1240x1240. Pediatric retinal photograph (wide-field) — 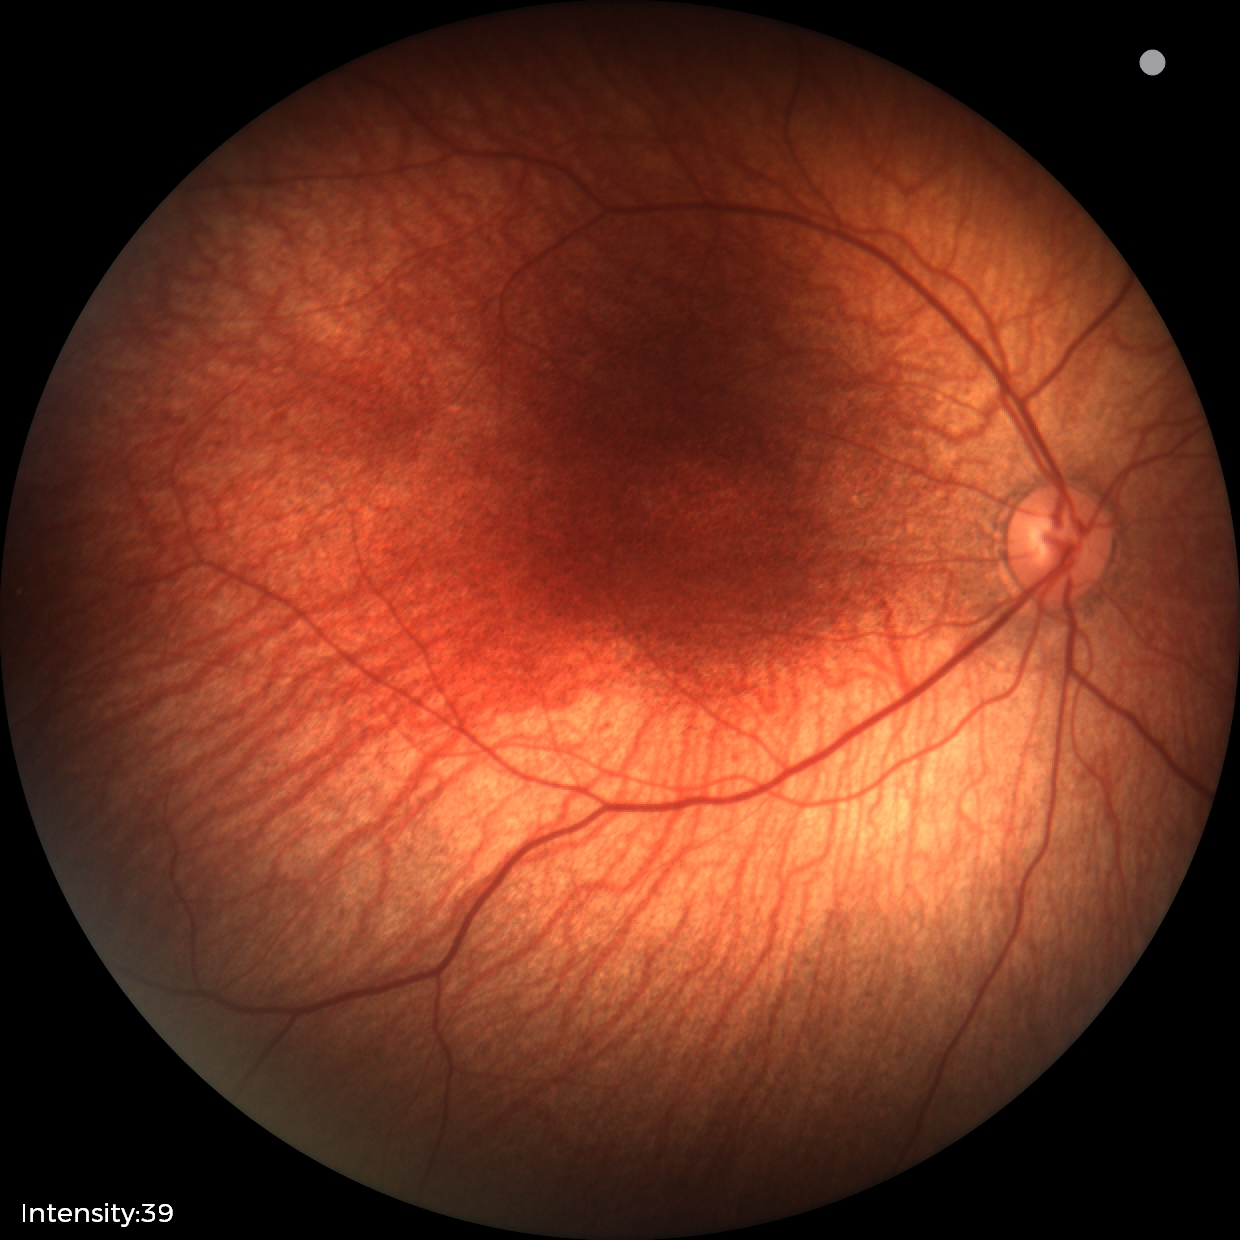

Screening examination with no abnormal retinal findings.